Image size 1659x2212. Camera: Remidio FOP fundus camera:
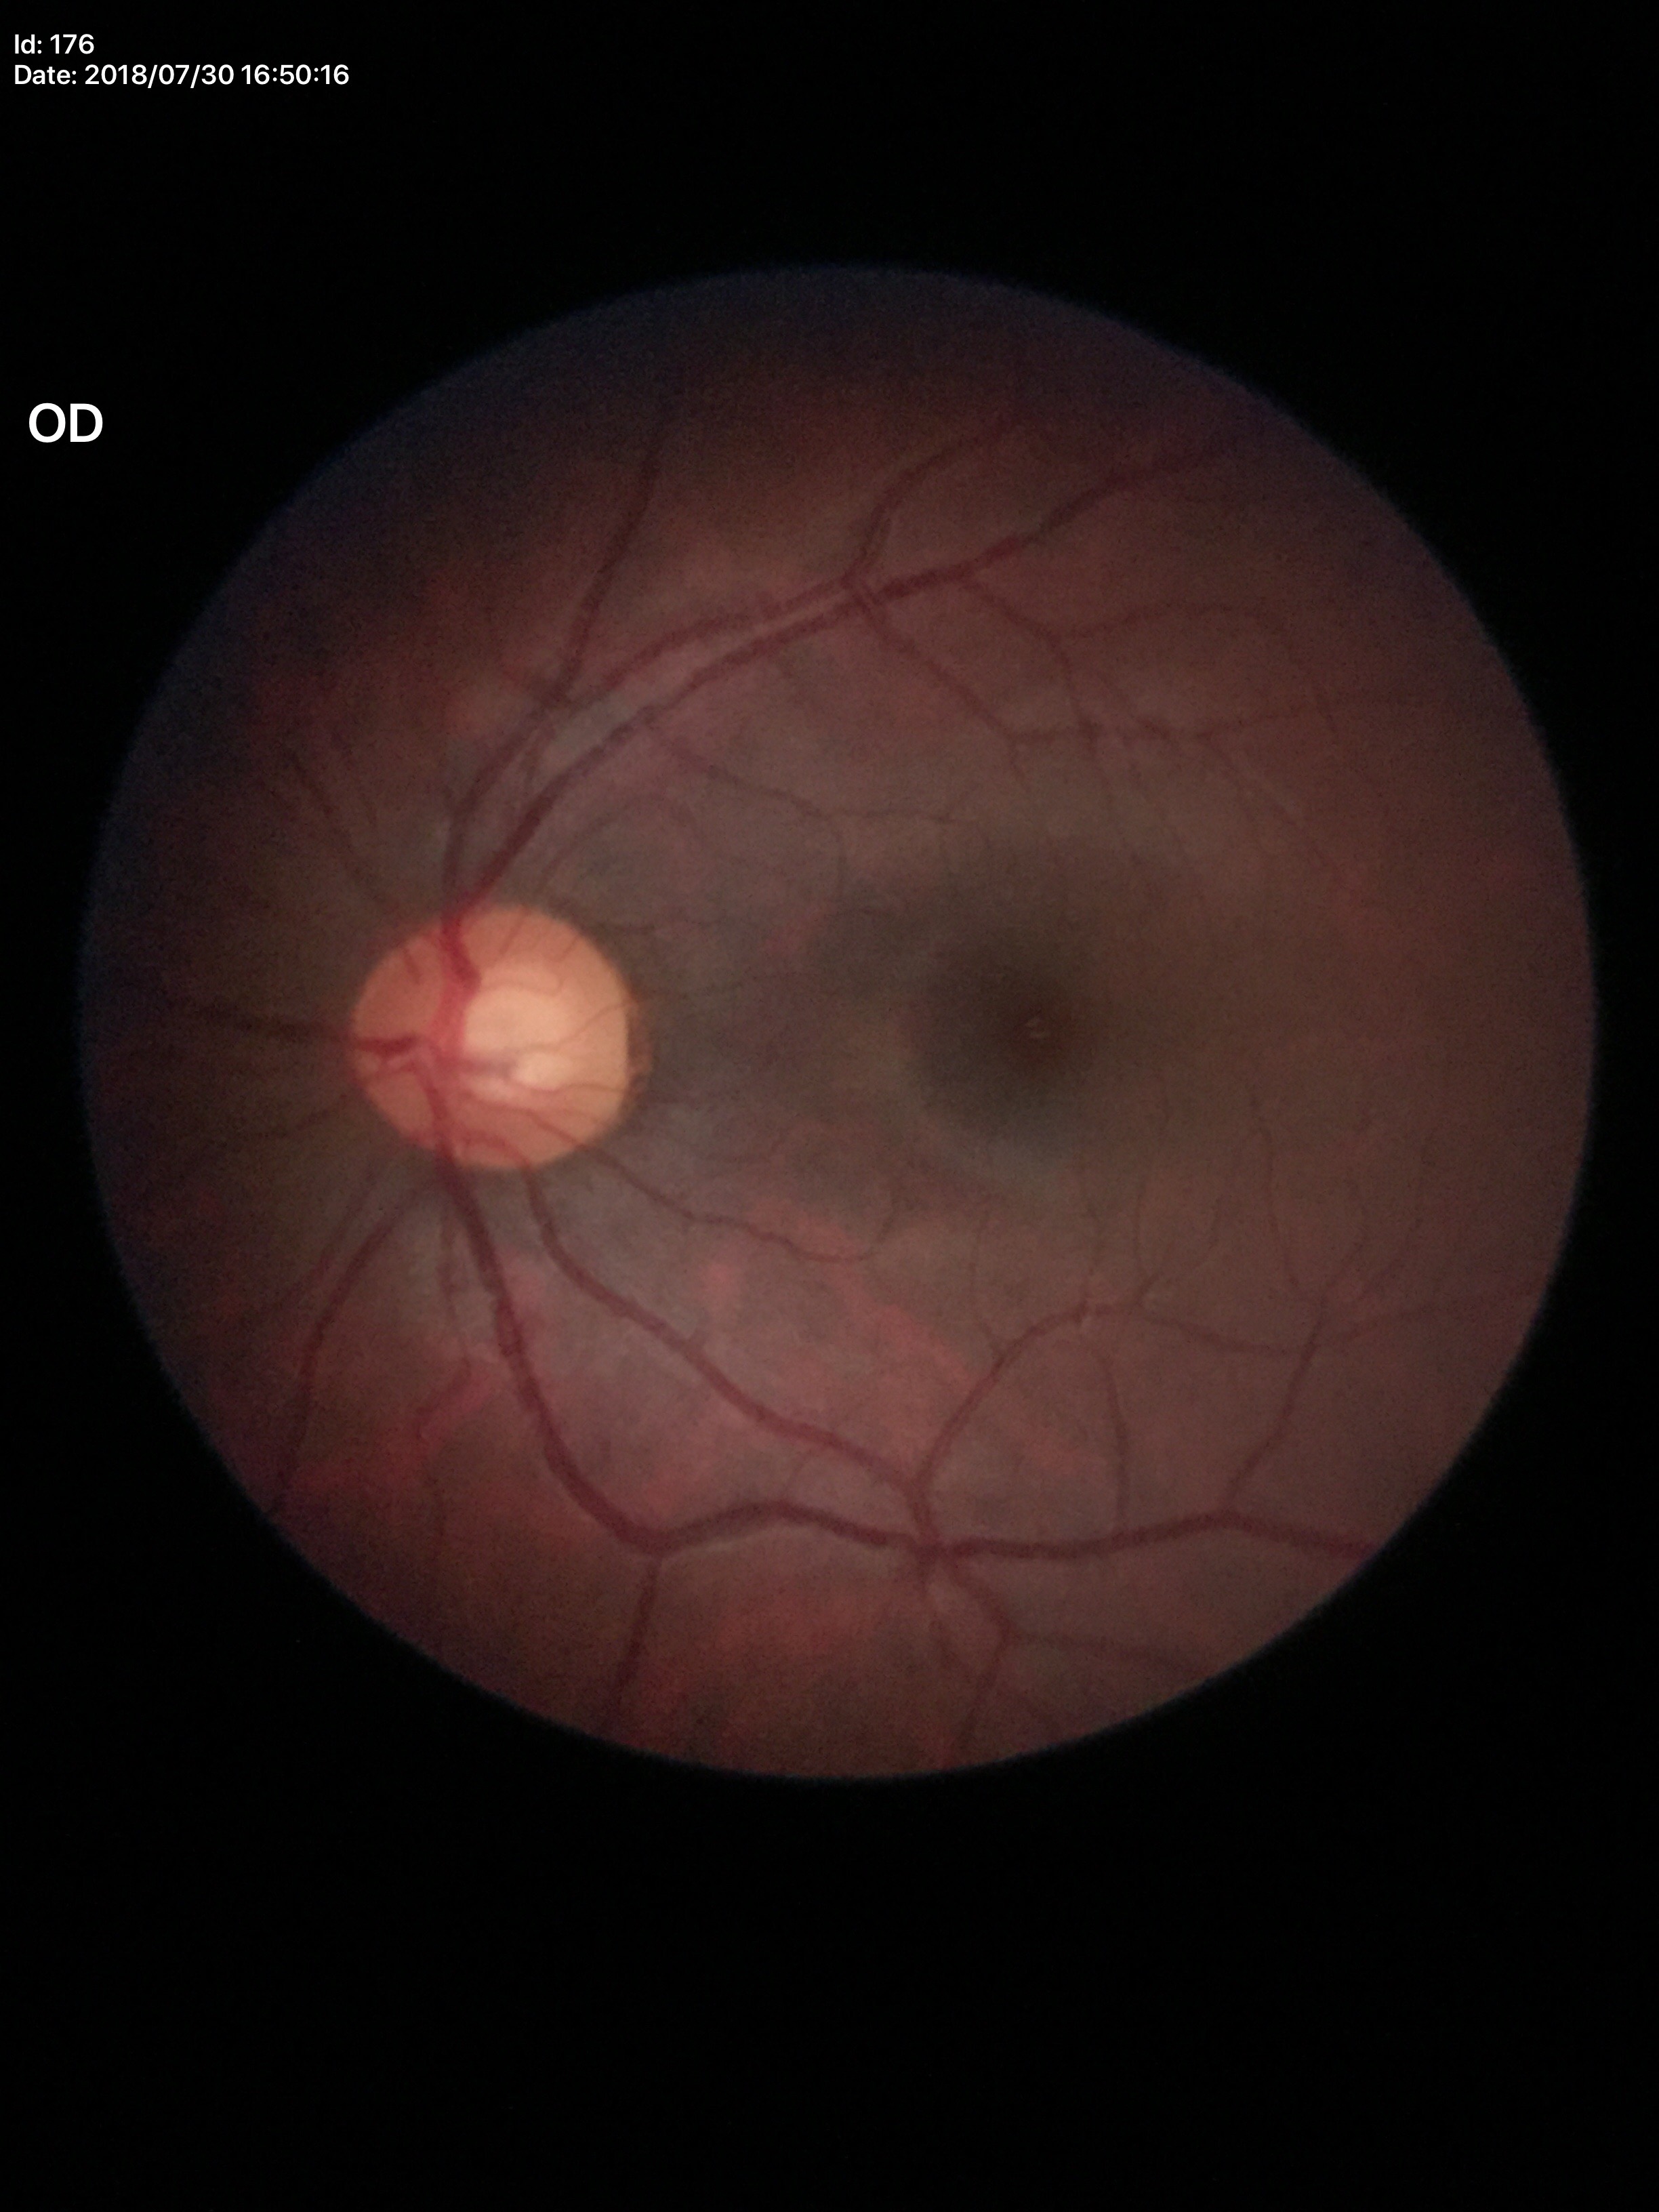
Glaucoma evaluation: suspect, vertical cup-disc ratio: 0.59.